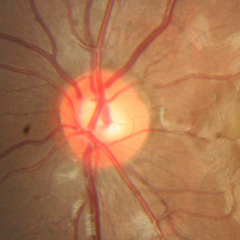
Glaucoma assessment = no glaucoma.